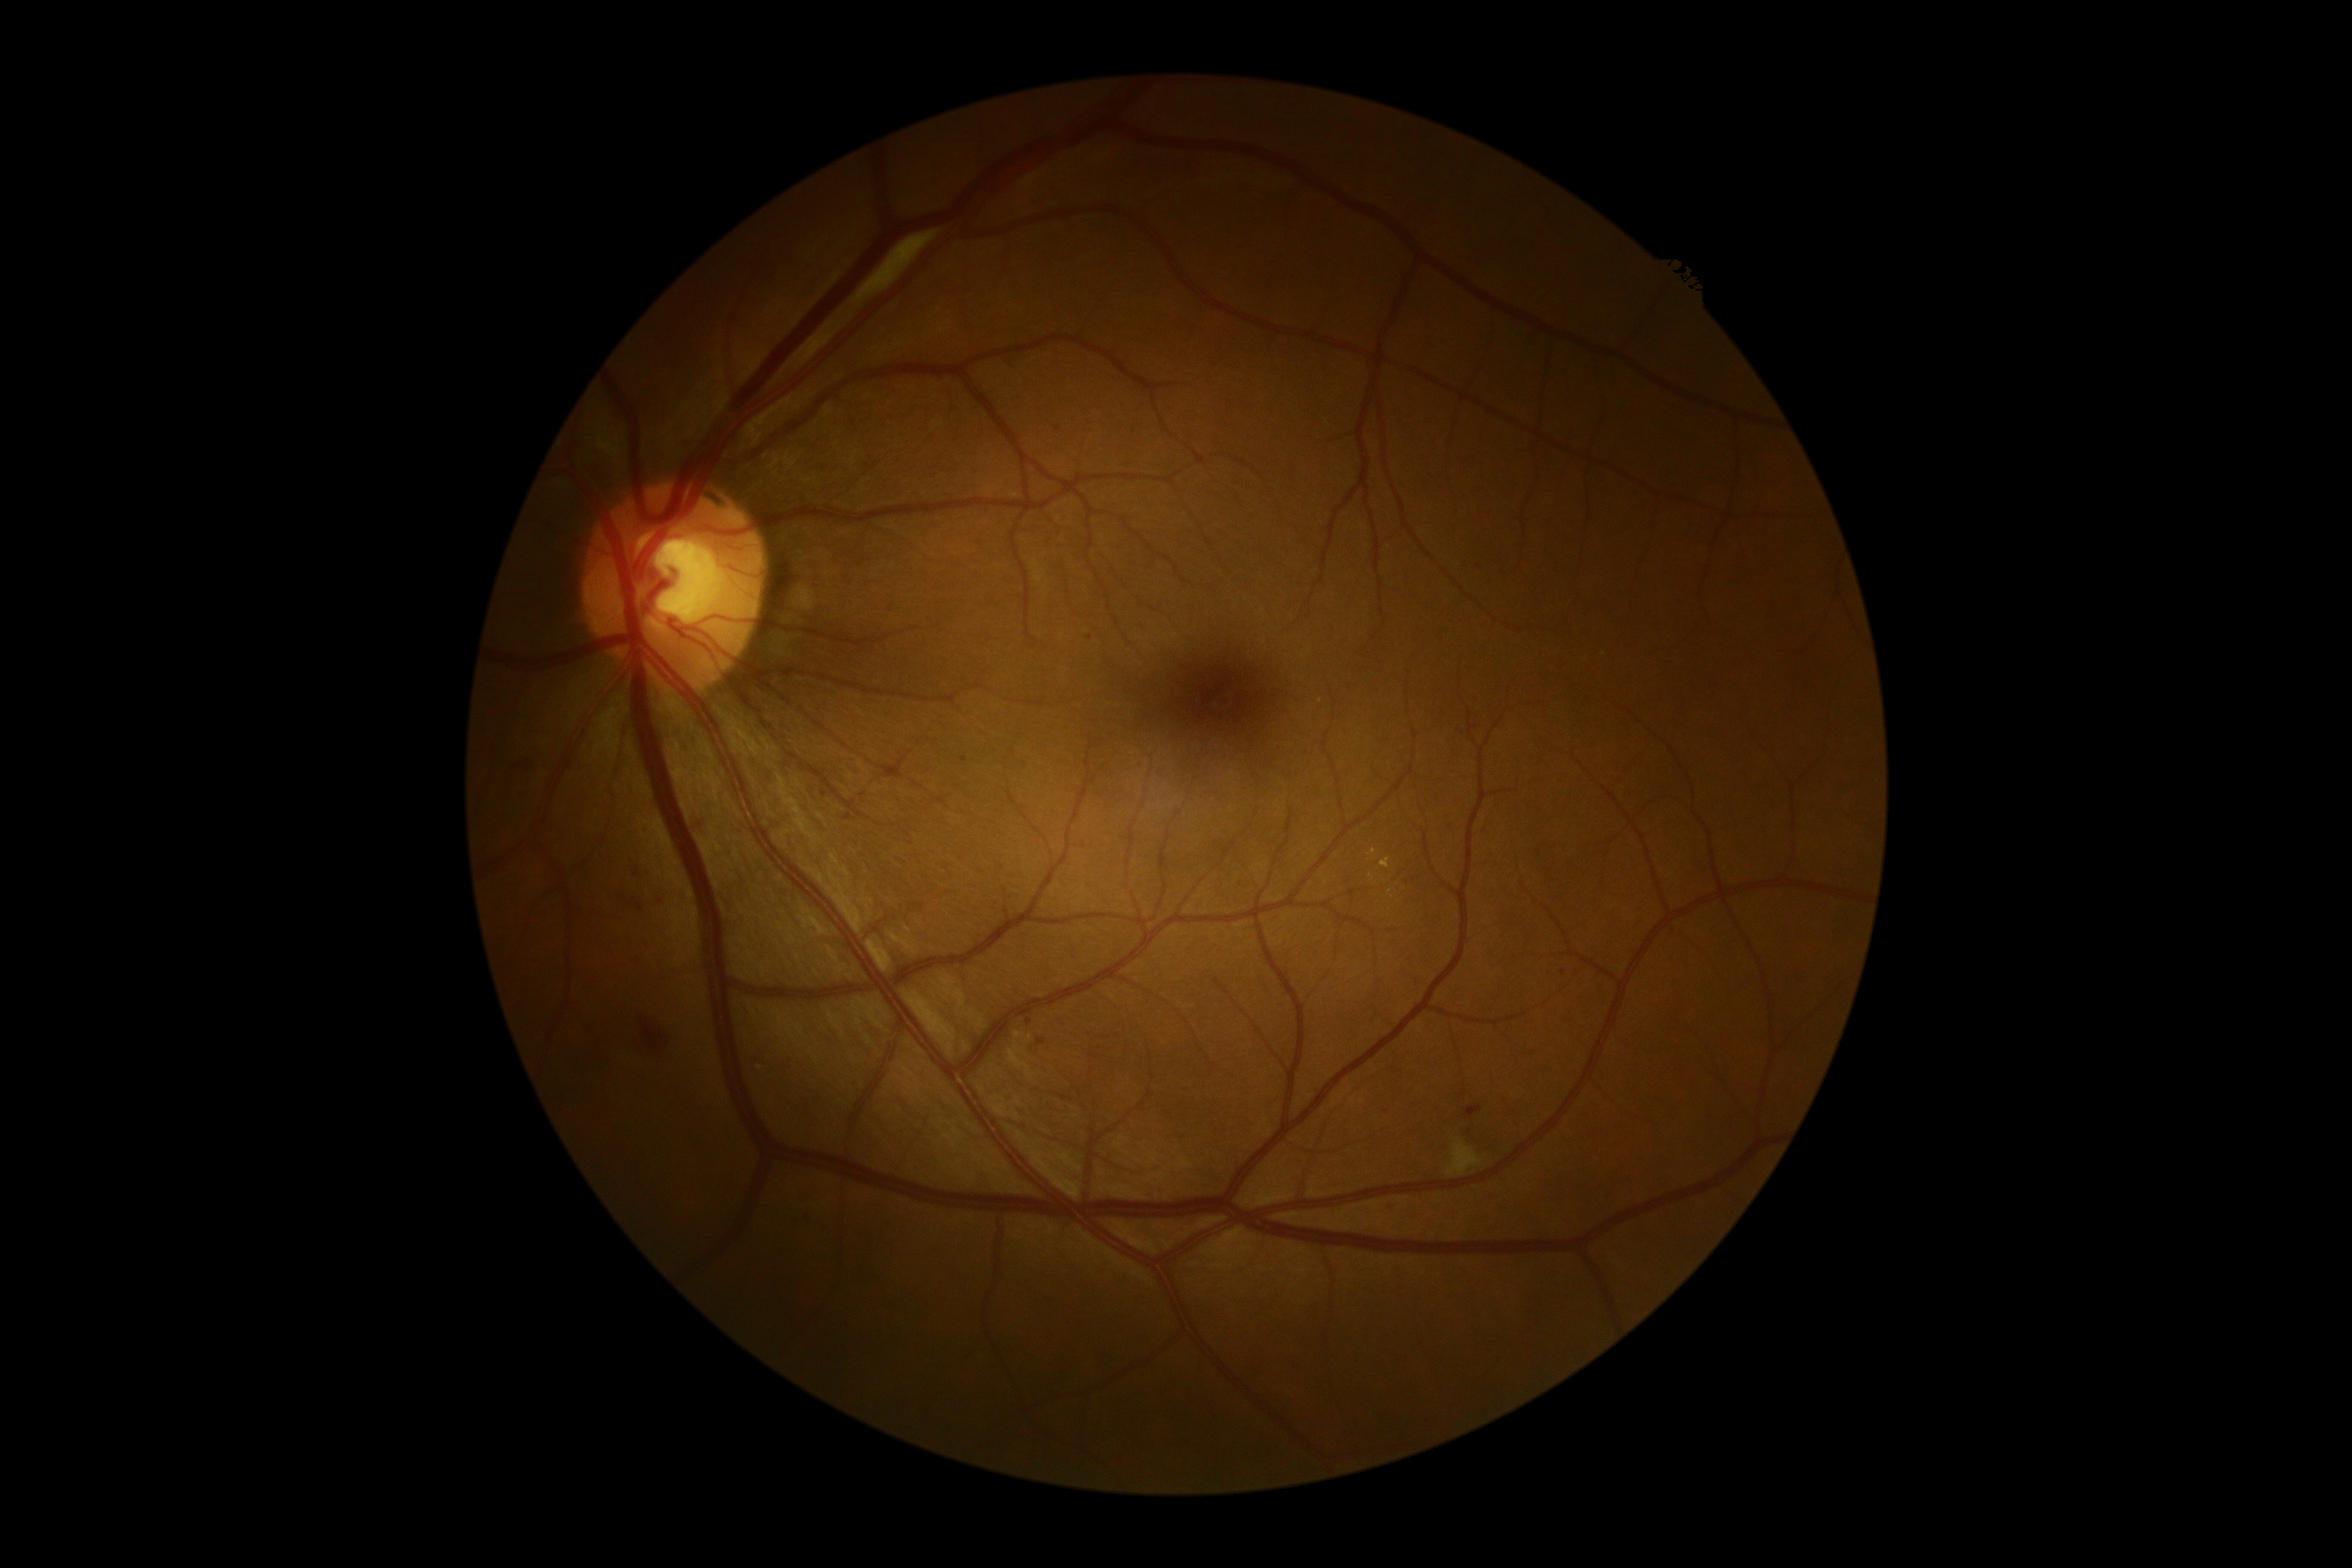
  dr_grade: 2